Retinal fundus photograph:
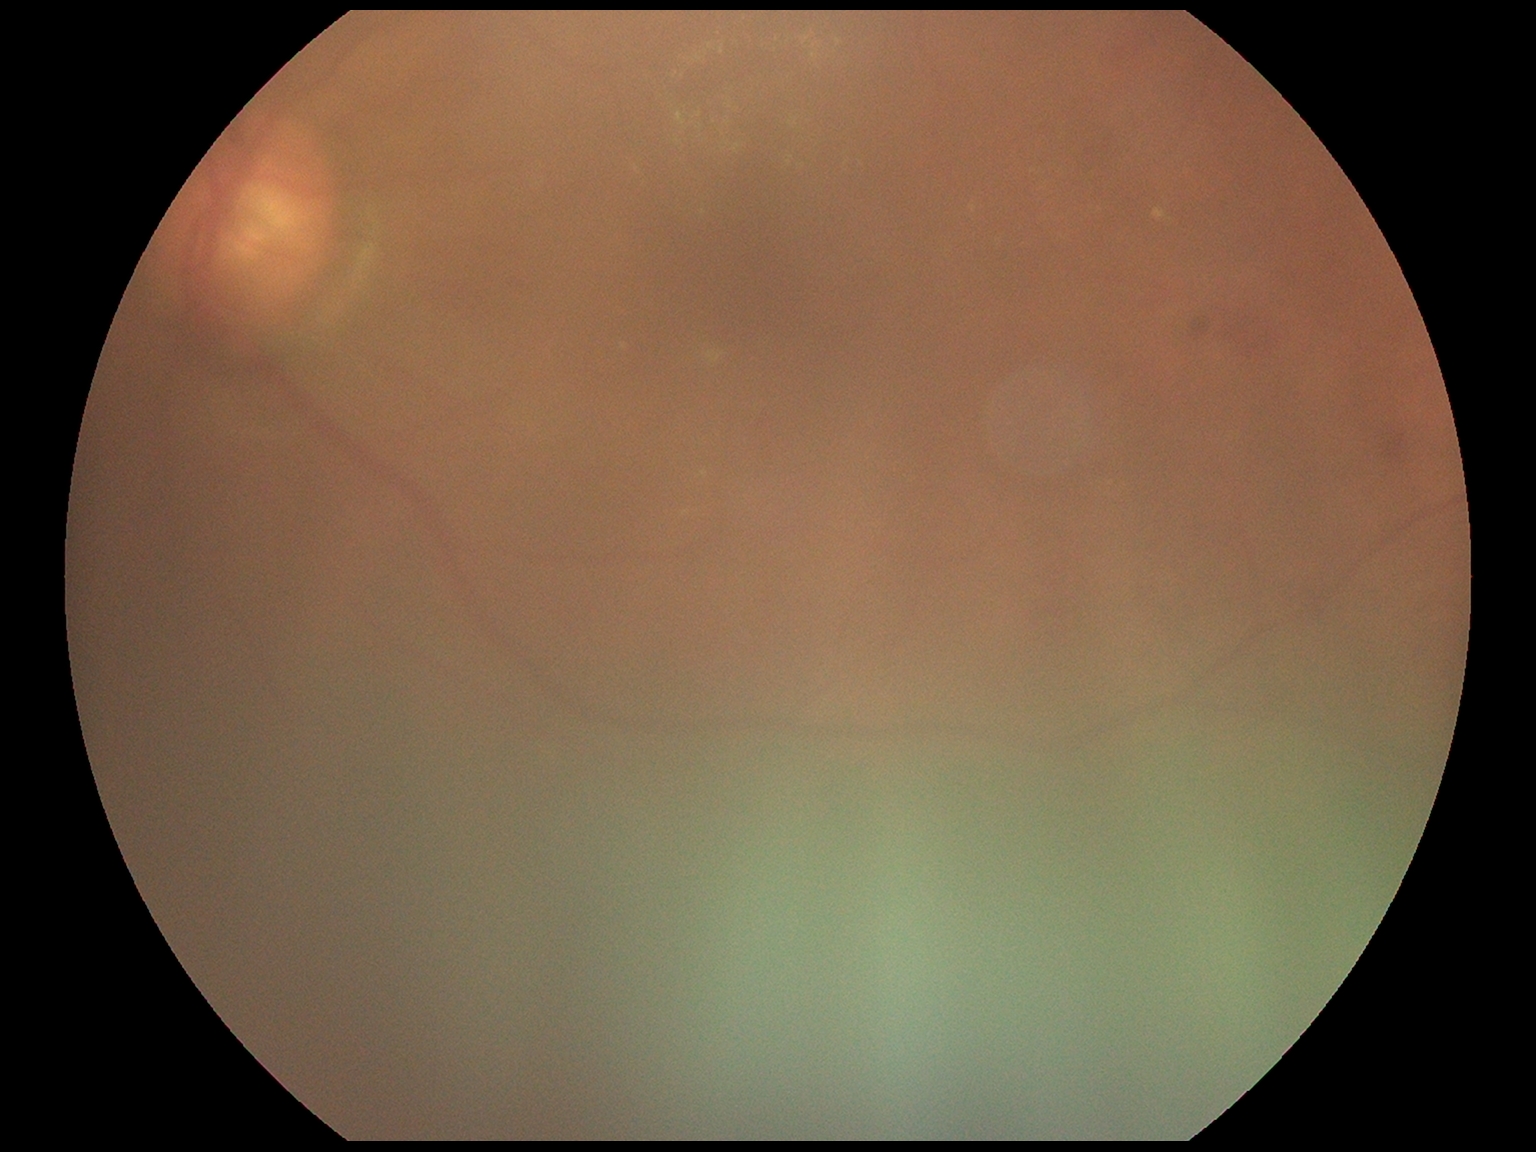

Findings:
- diabetic retinopathy: moderate non-proliferative diabetic retinopathy (grade 2)